Wide-field fundus image from infant ROP screening · 130° field of view (Natus RetCam Envision).
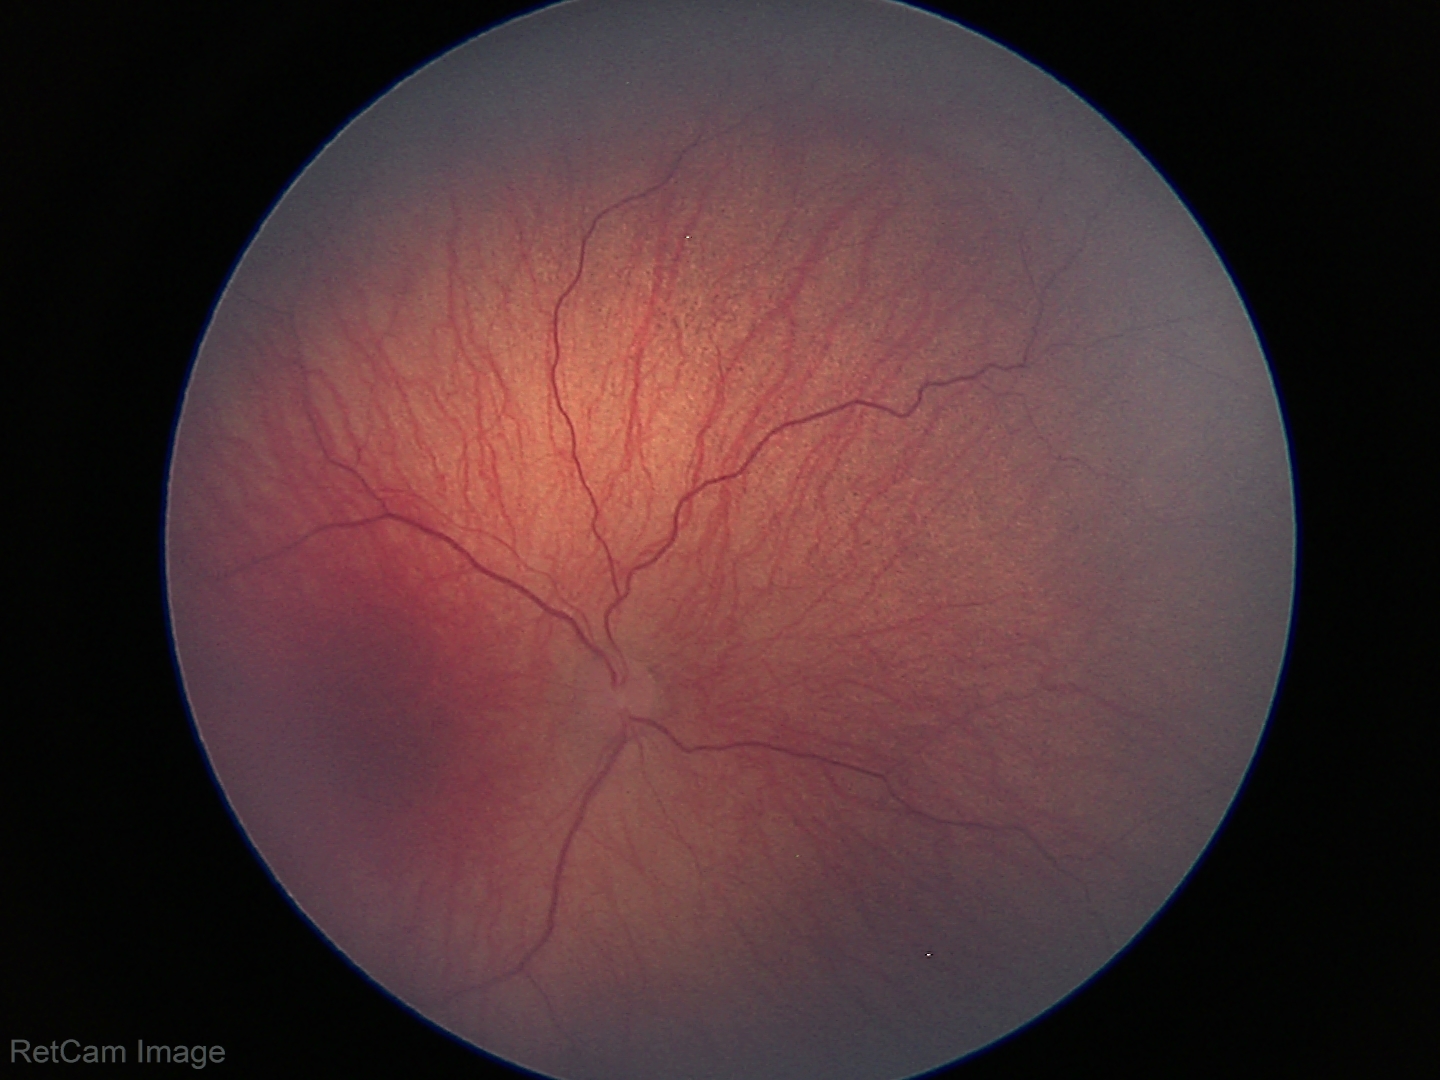 Plus disease absent.
Examination diagnosed as retinopathy of prematurity stage 1.